Color fundus image; 2212 by 1659 pixels; FOV: 45 degrees
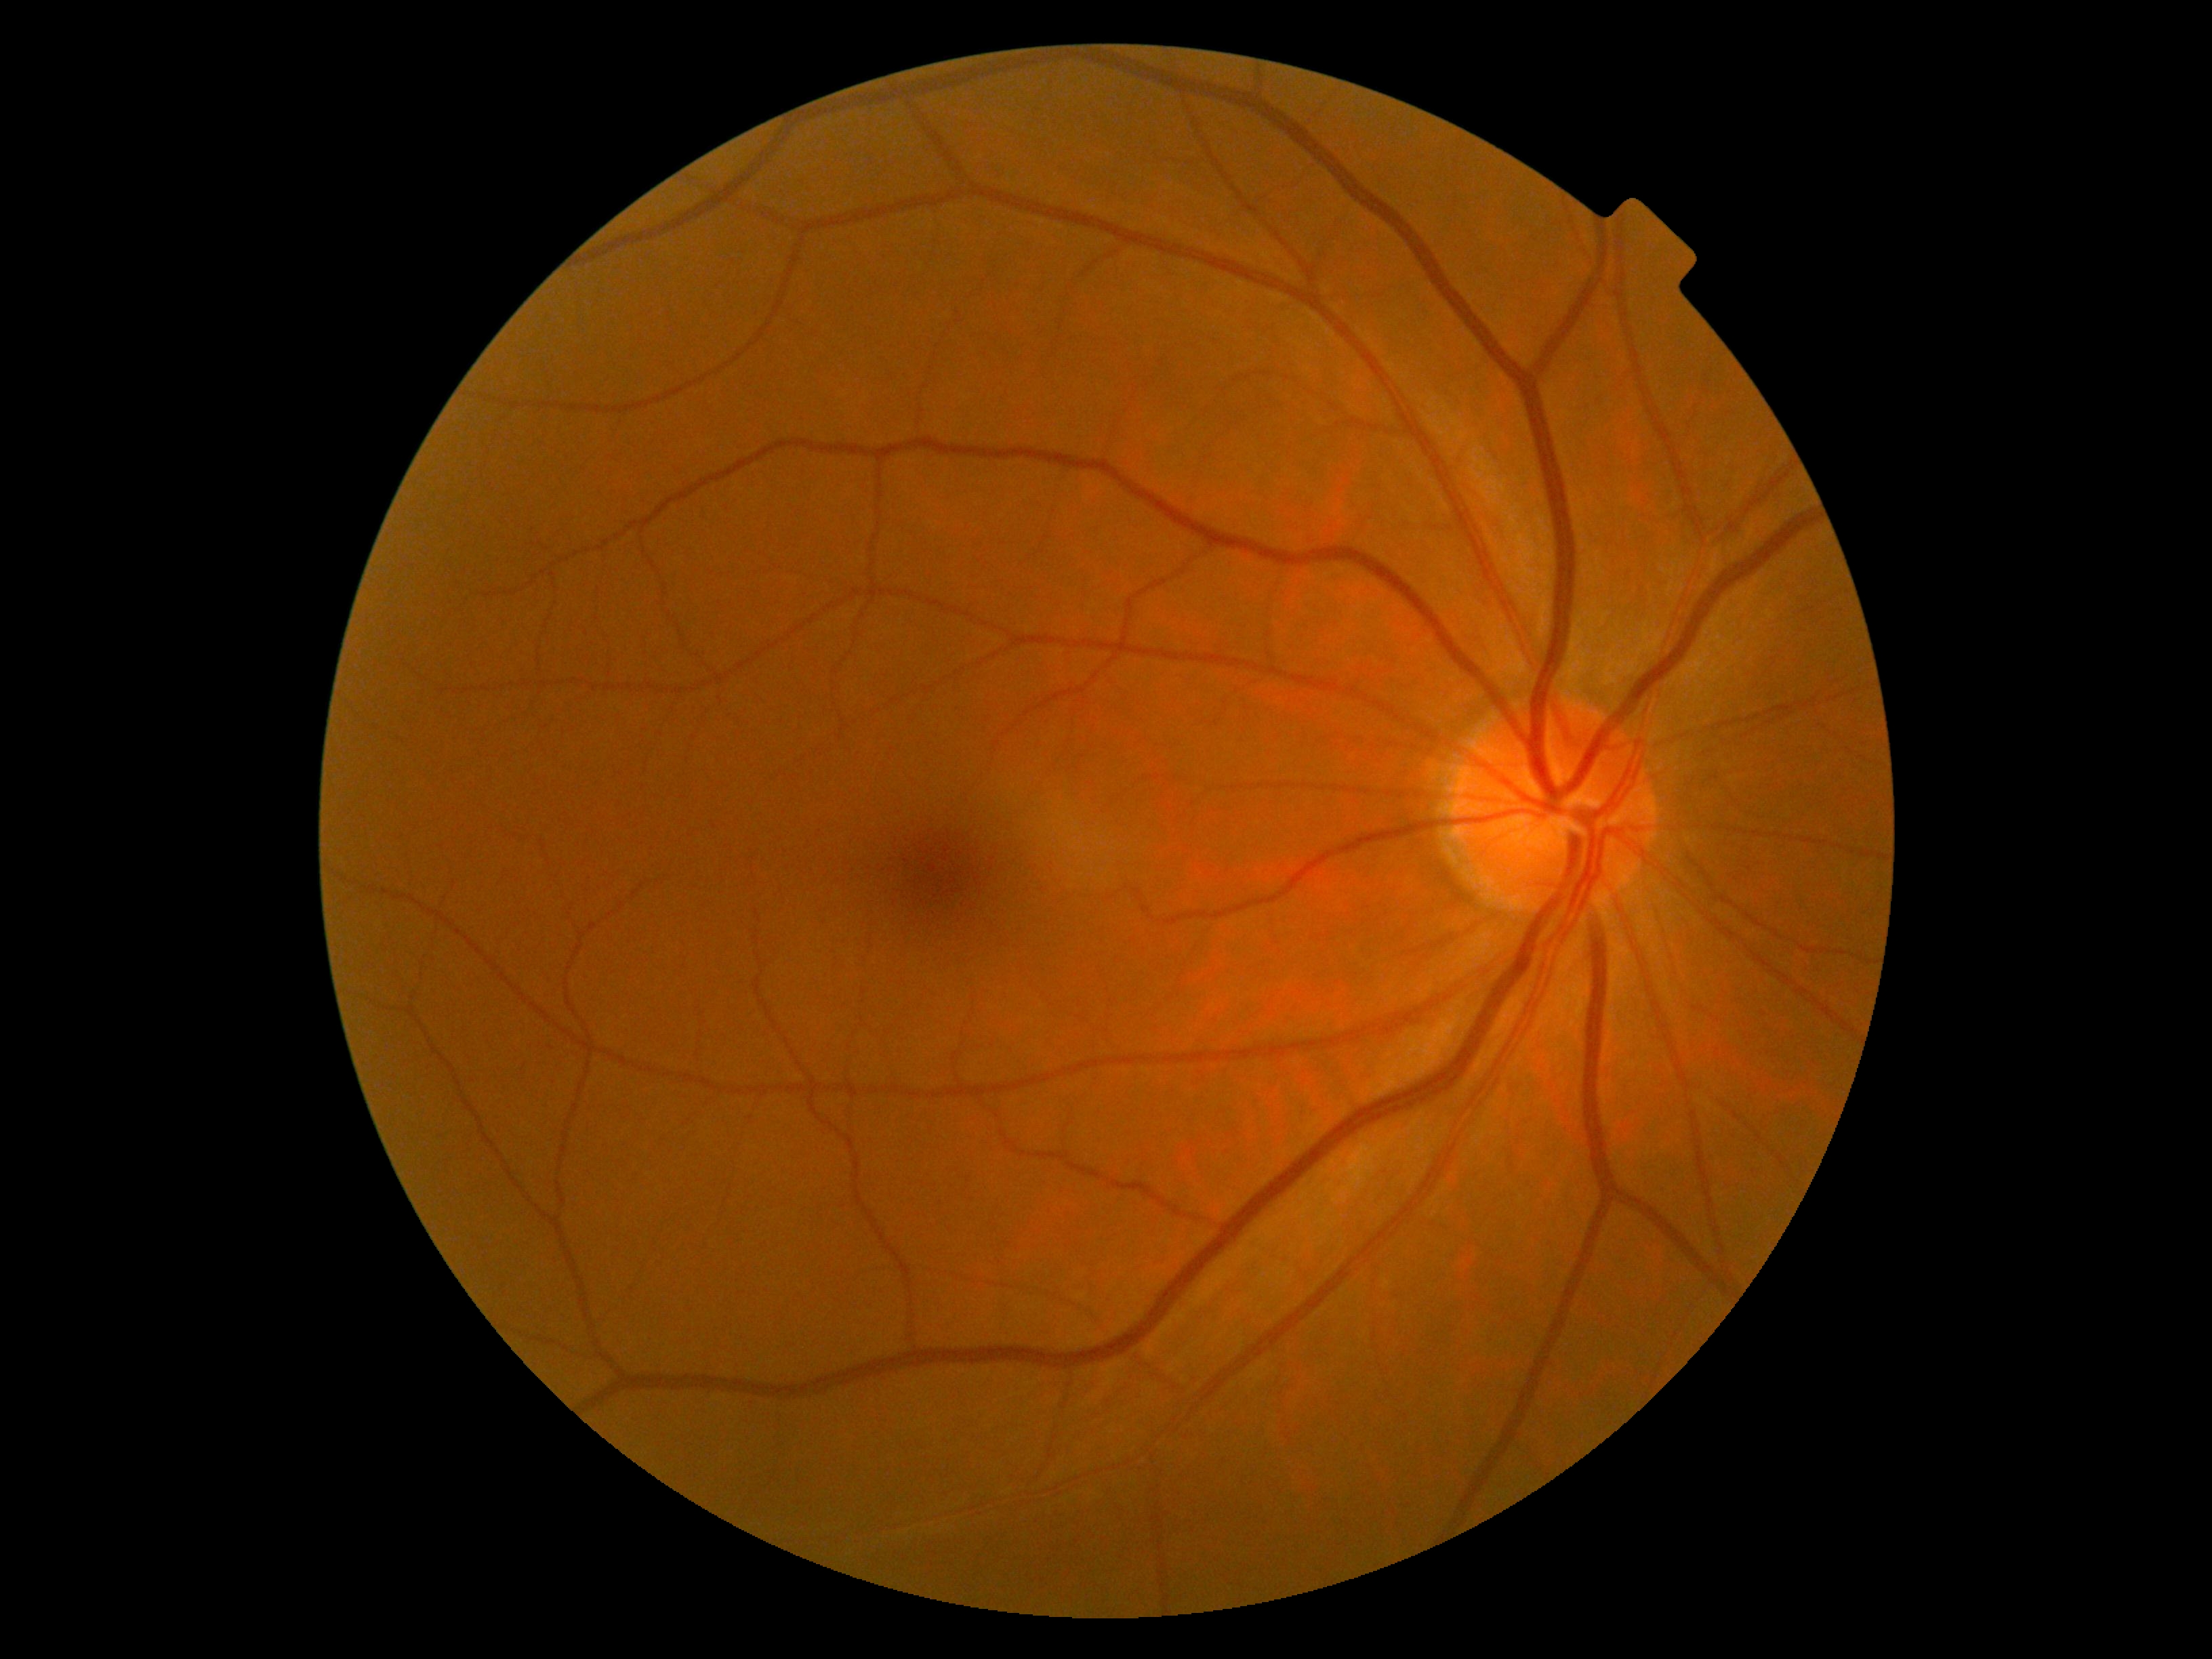

DR grade is 0 (no apparent retinopathy) — no visible signs of diabetic retinopathy.